2048x1536 · CFP.
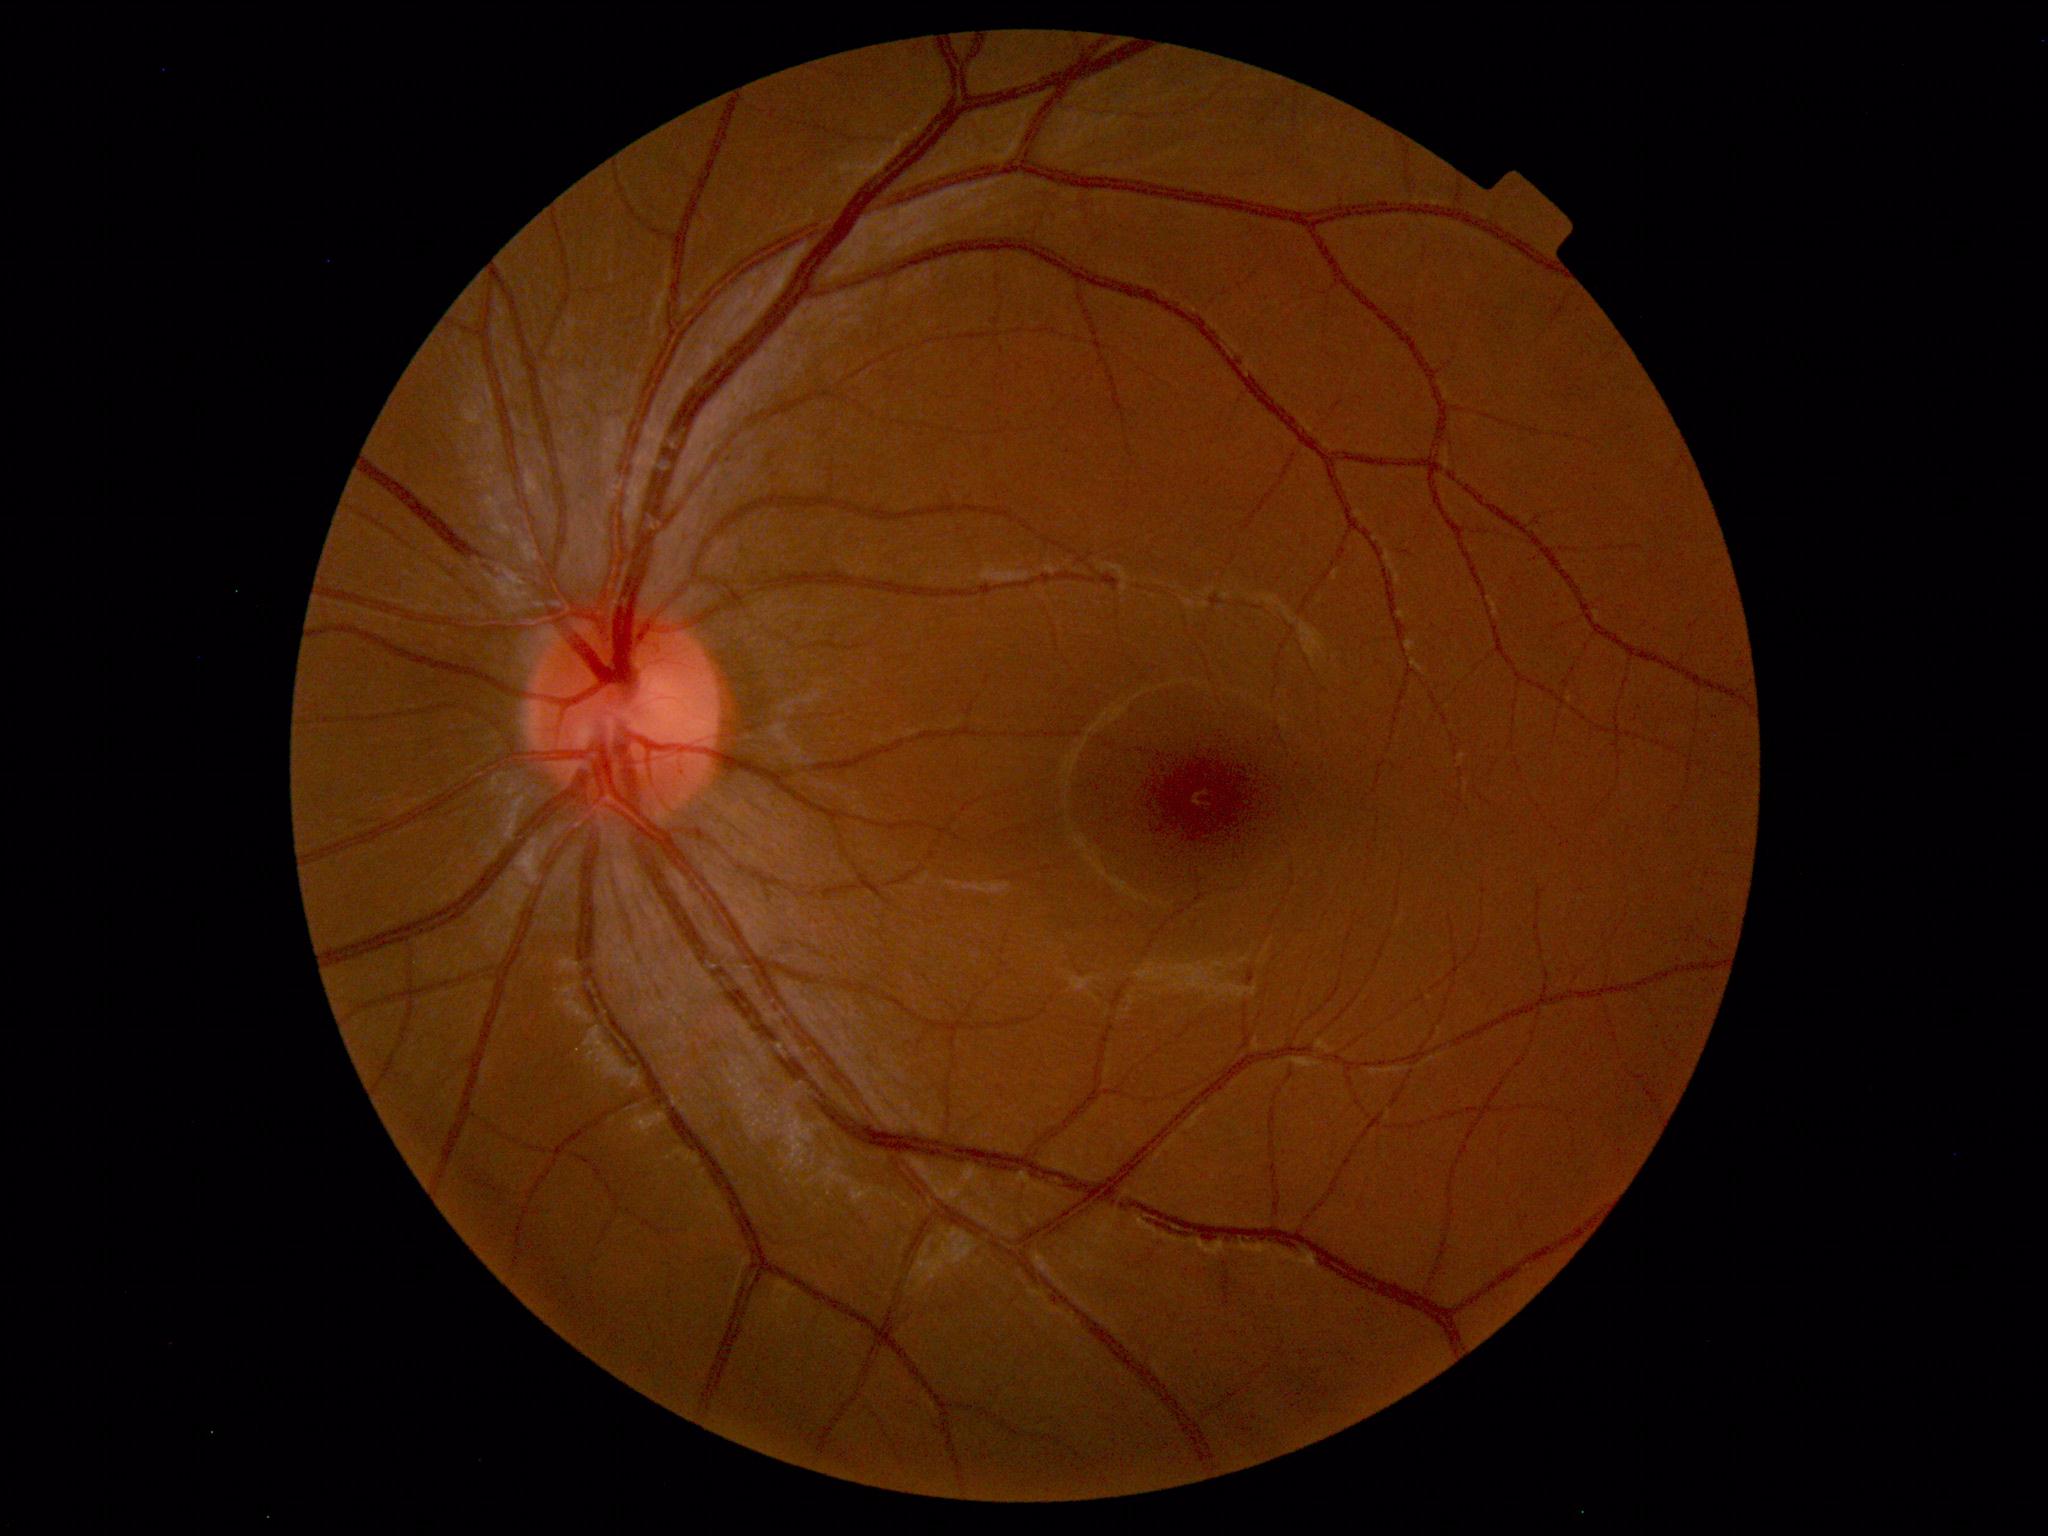
Impression: normal fundus.